Camera: Topcon TRC. Dilated pupil. Fundus image cropped to the optic disc: 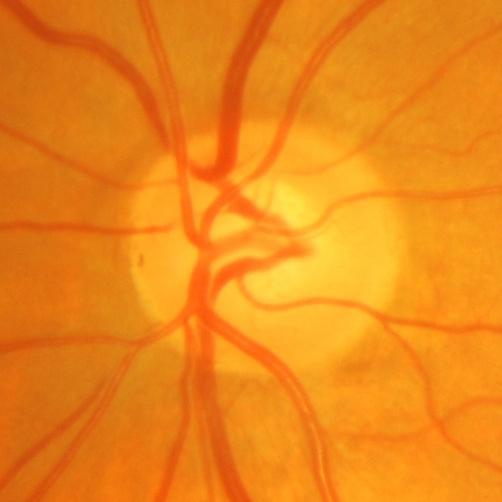

Glaucoma assessment = glaucomatous changes.